Pediatric wide-field fundus photograph; 130° field of view (Clarity RetCam 3).
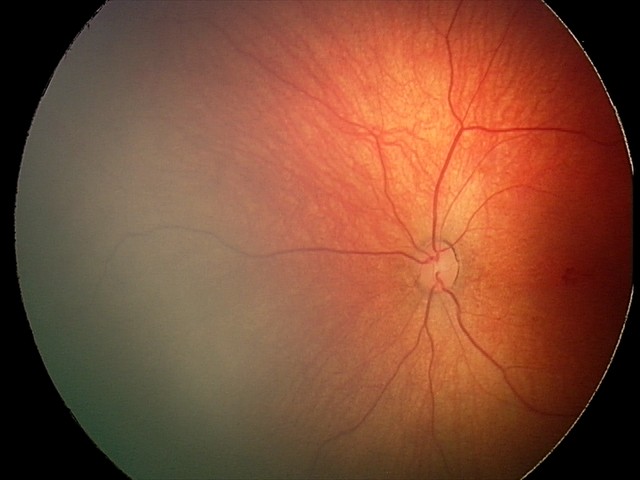

Screening series with retinal hemorrhages.